Nonmydriatic fundus photograph. 848 by 848 pixels.
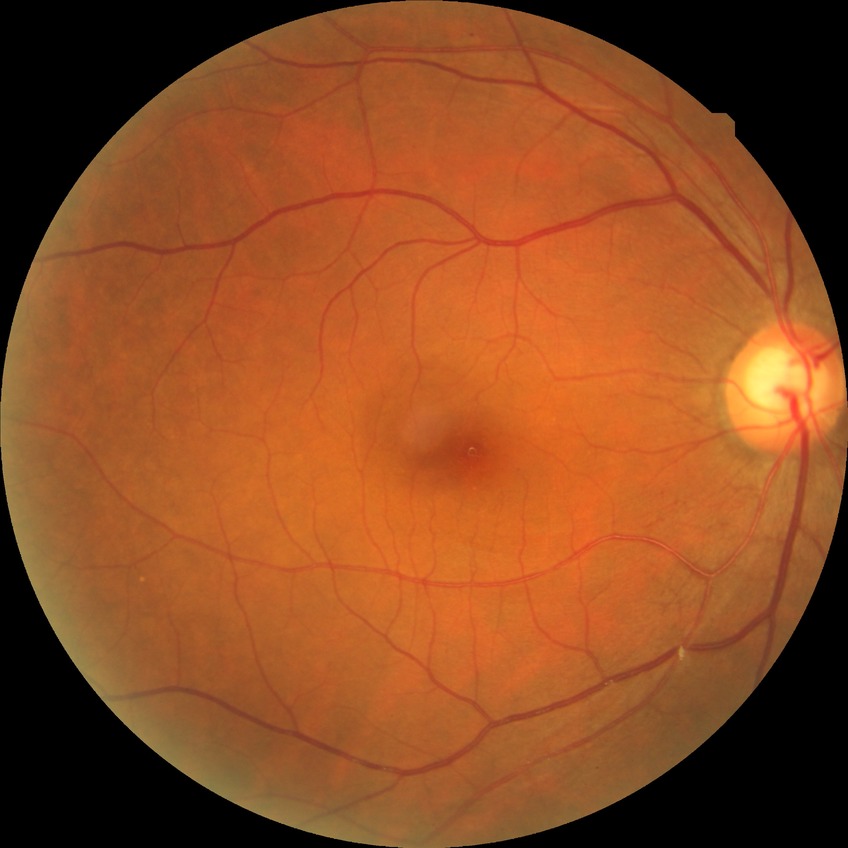

diabetic retinopathy (DR) = NDR (no diabetic retinopathy).